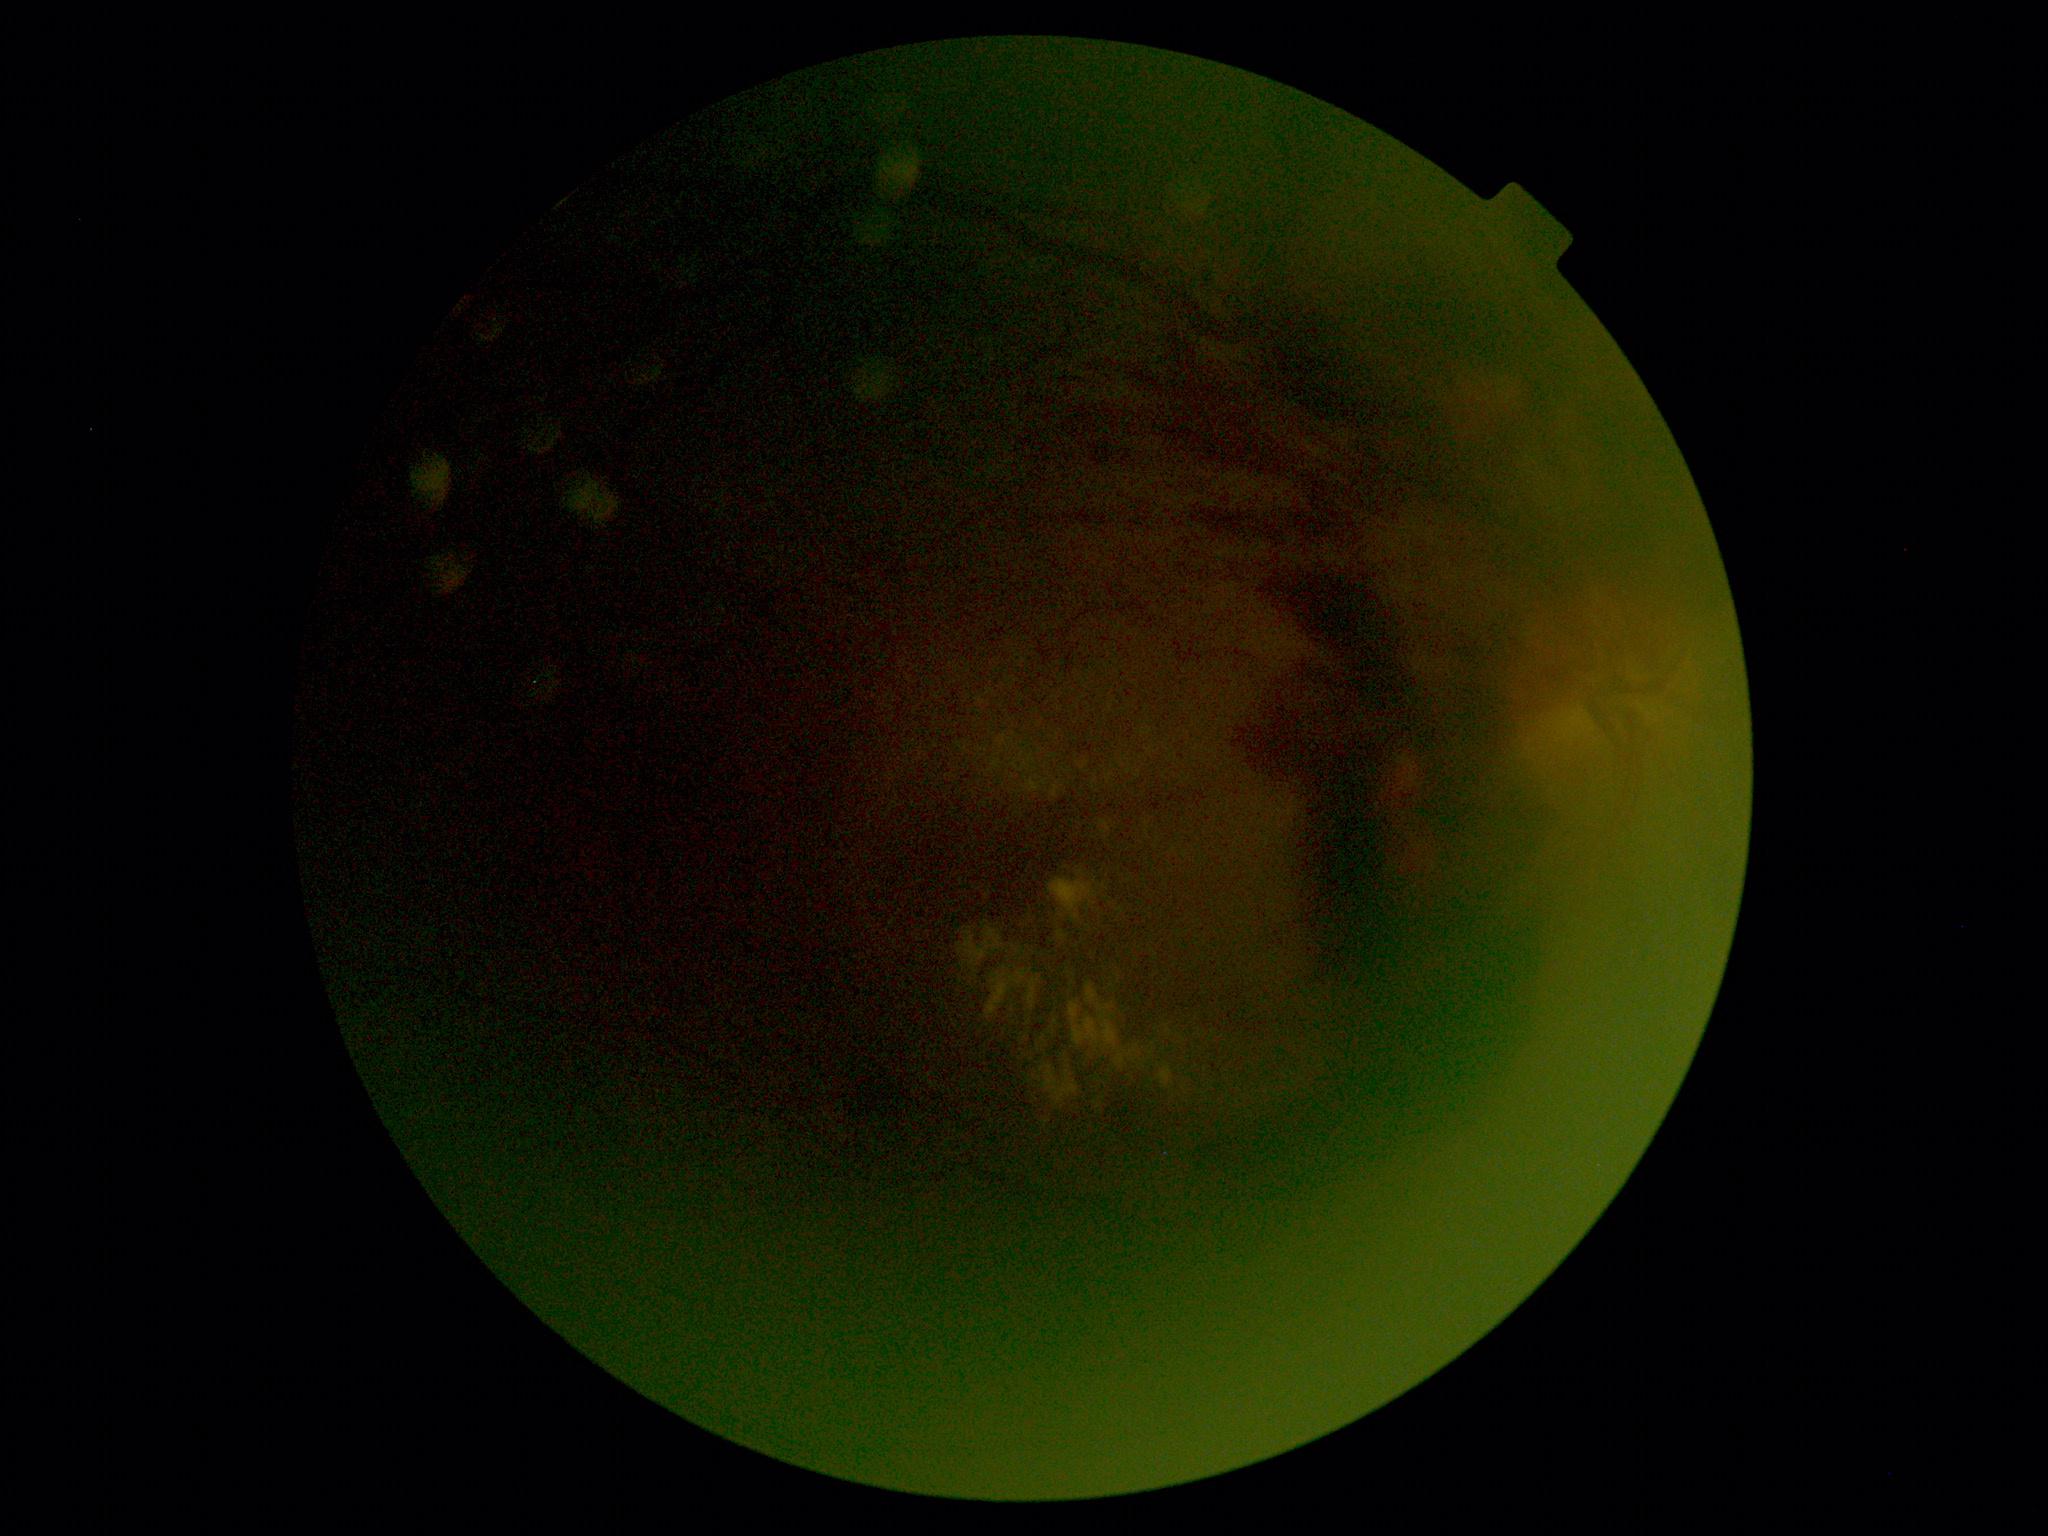

Diabetic retinopathy grade: 4 (PDR).